2352 by 1568 pixels — 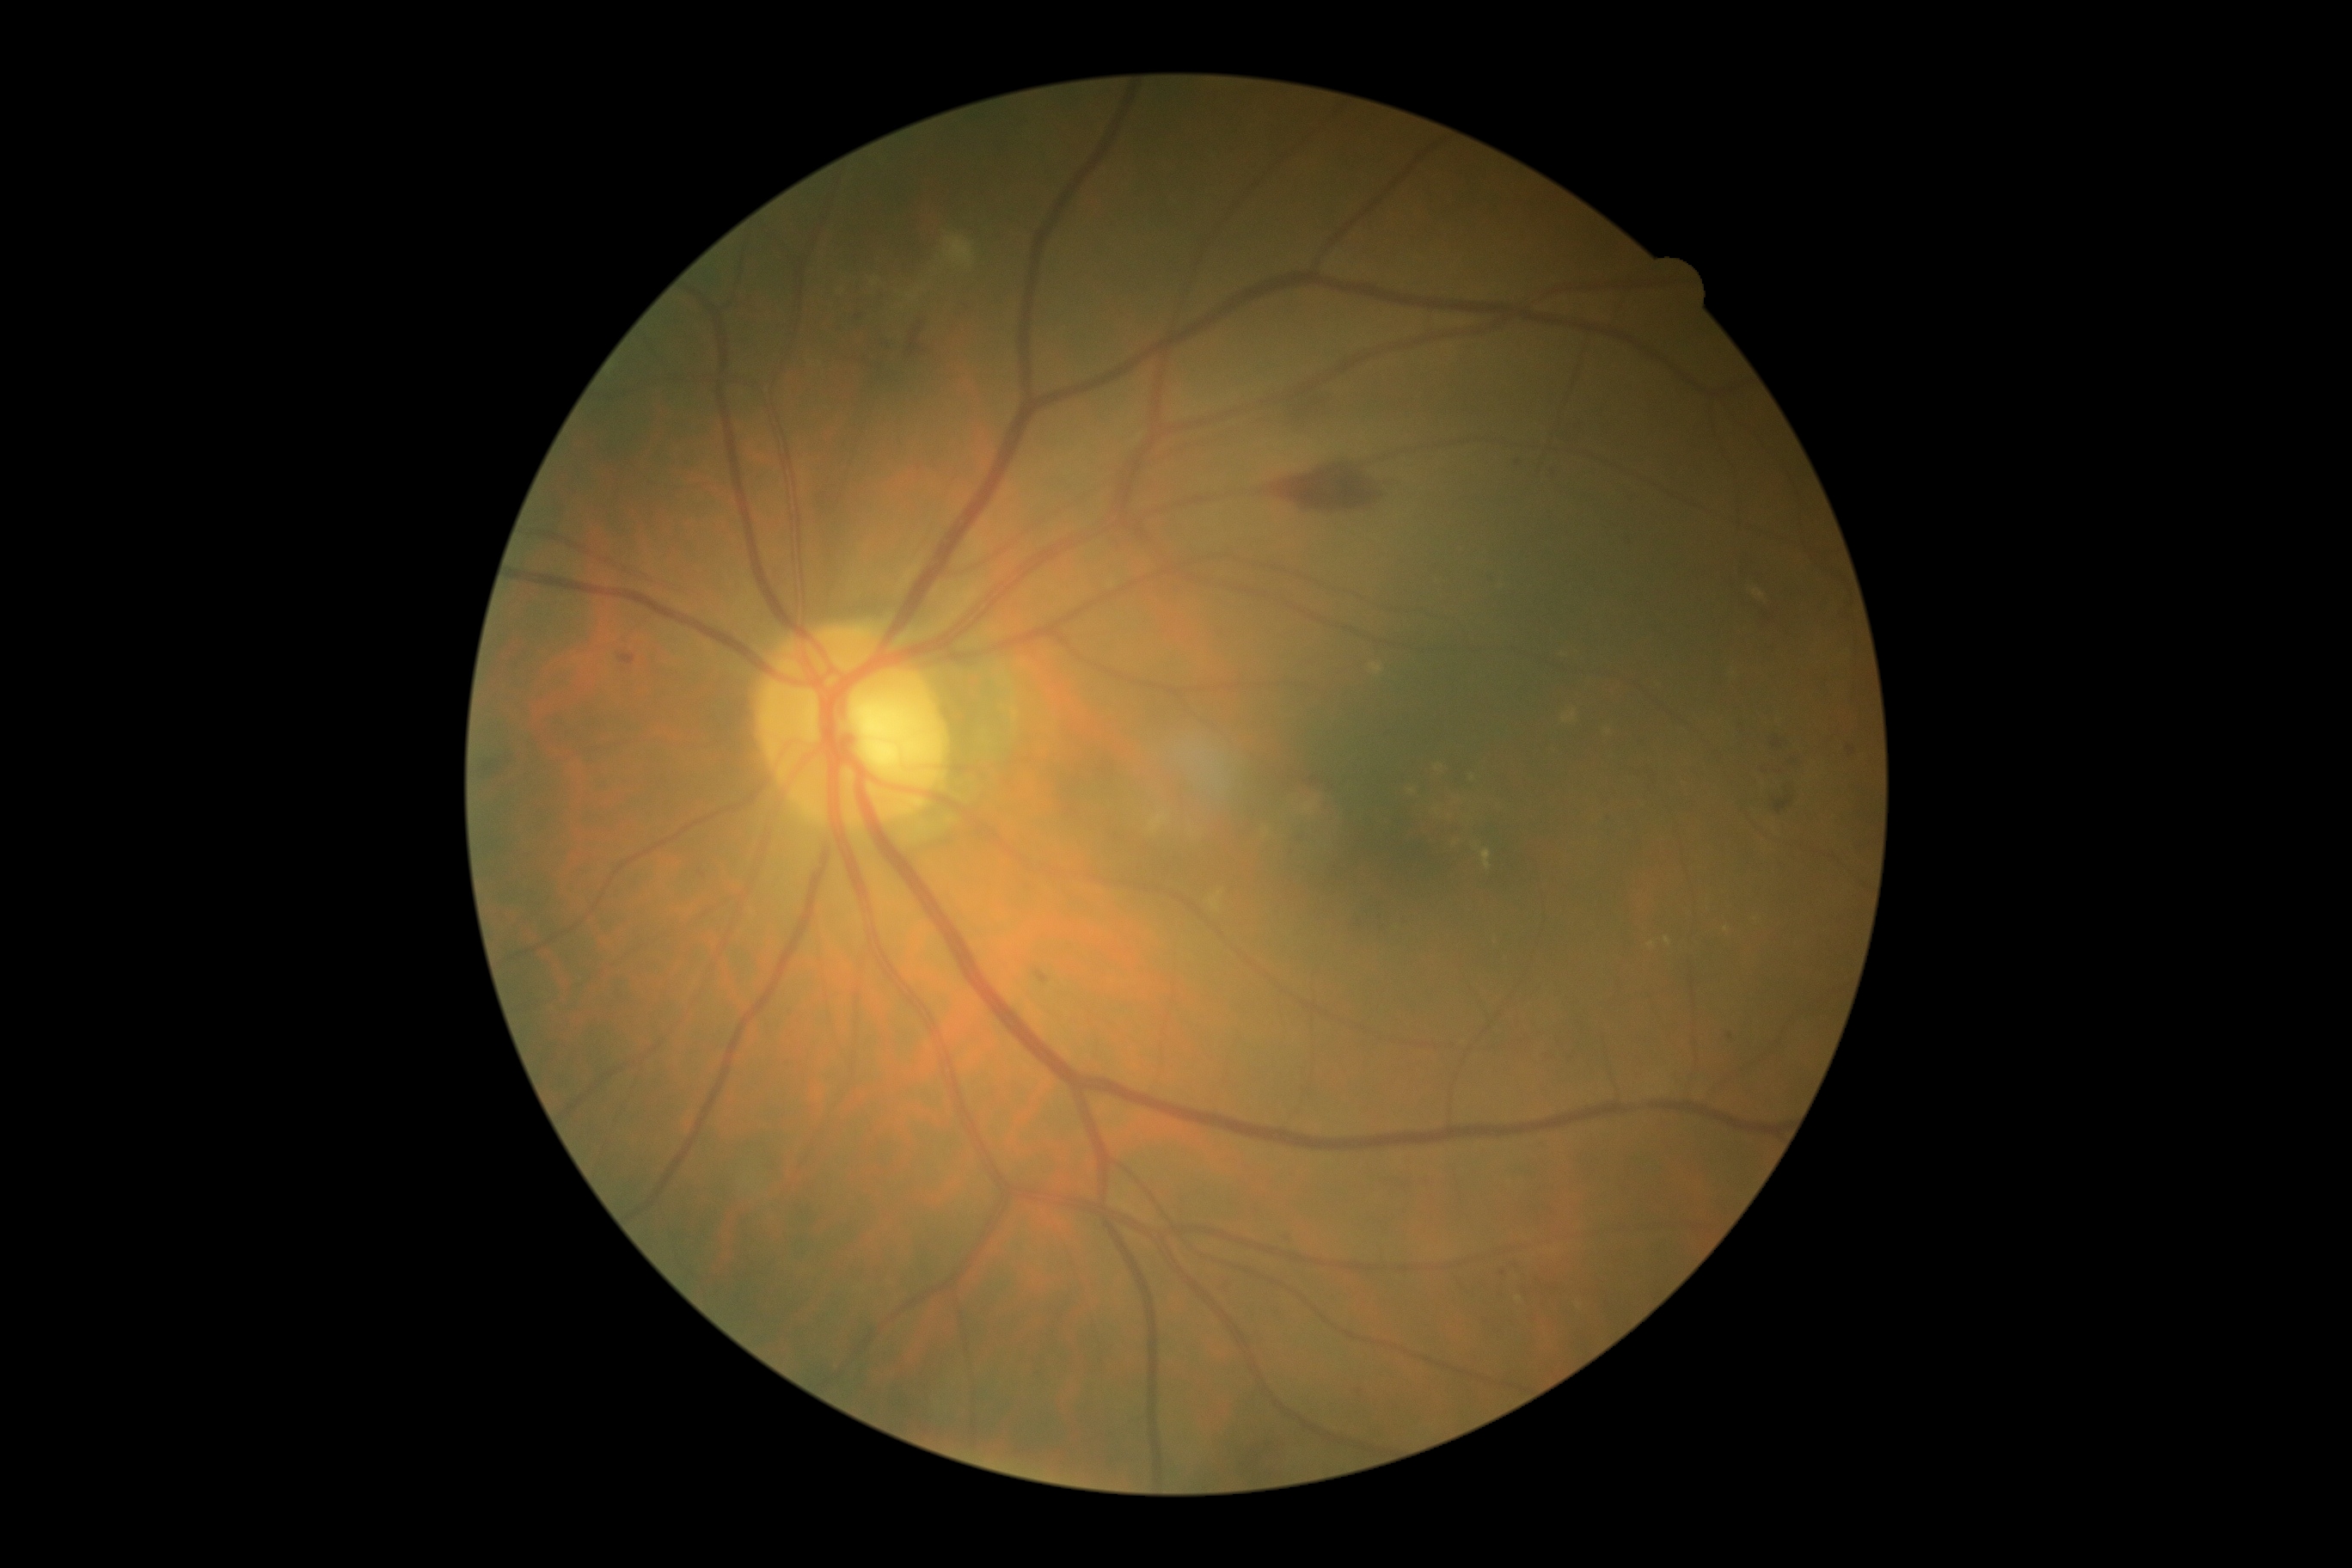

Diabetic retinopathy (DR): moderate NPDR (grade 2) — more than just microaneurysms but less than severe NPDR.